Nonmydriatic fundus photograph, posterior pole photograph, 45° field of view: 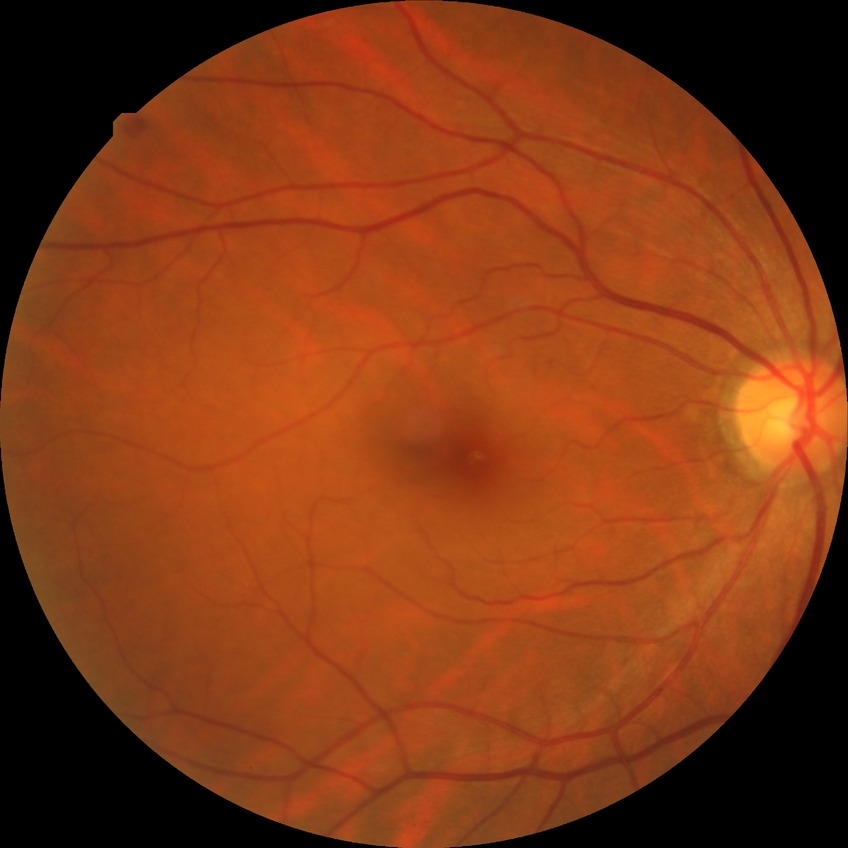

modified Davis classification: simple diabetic retinopathy.